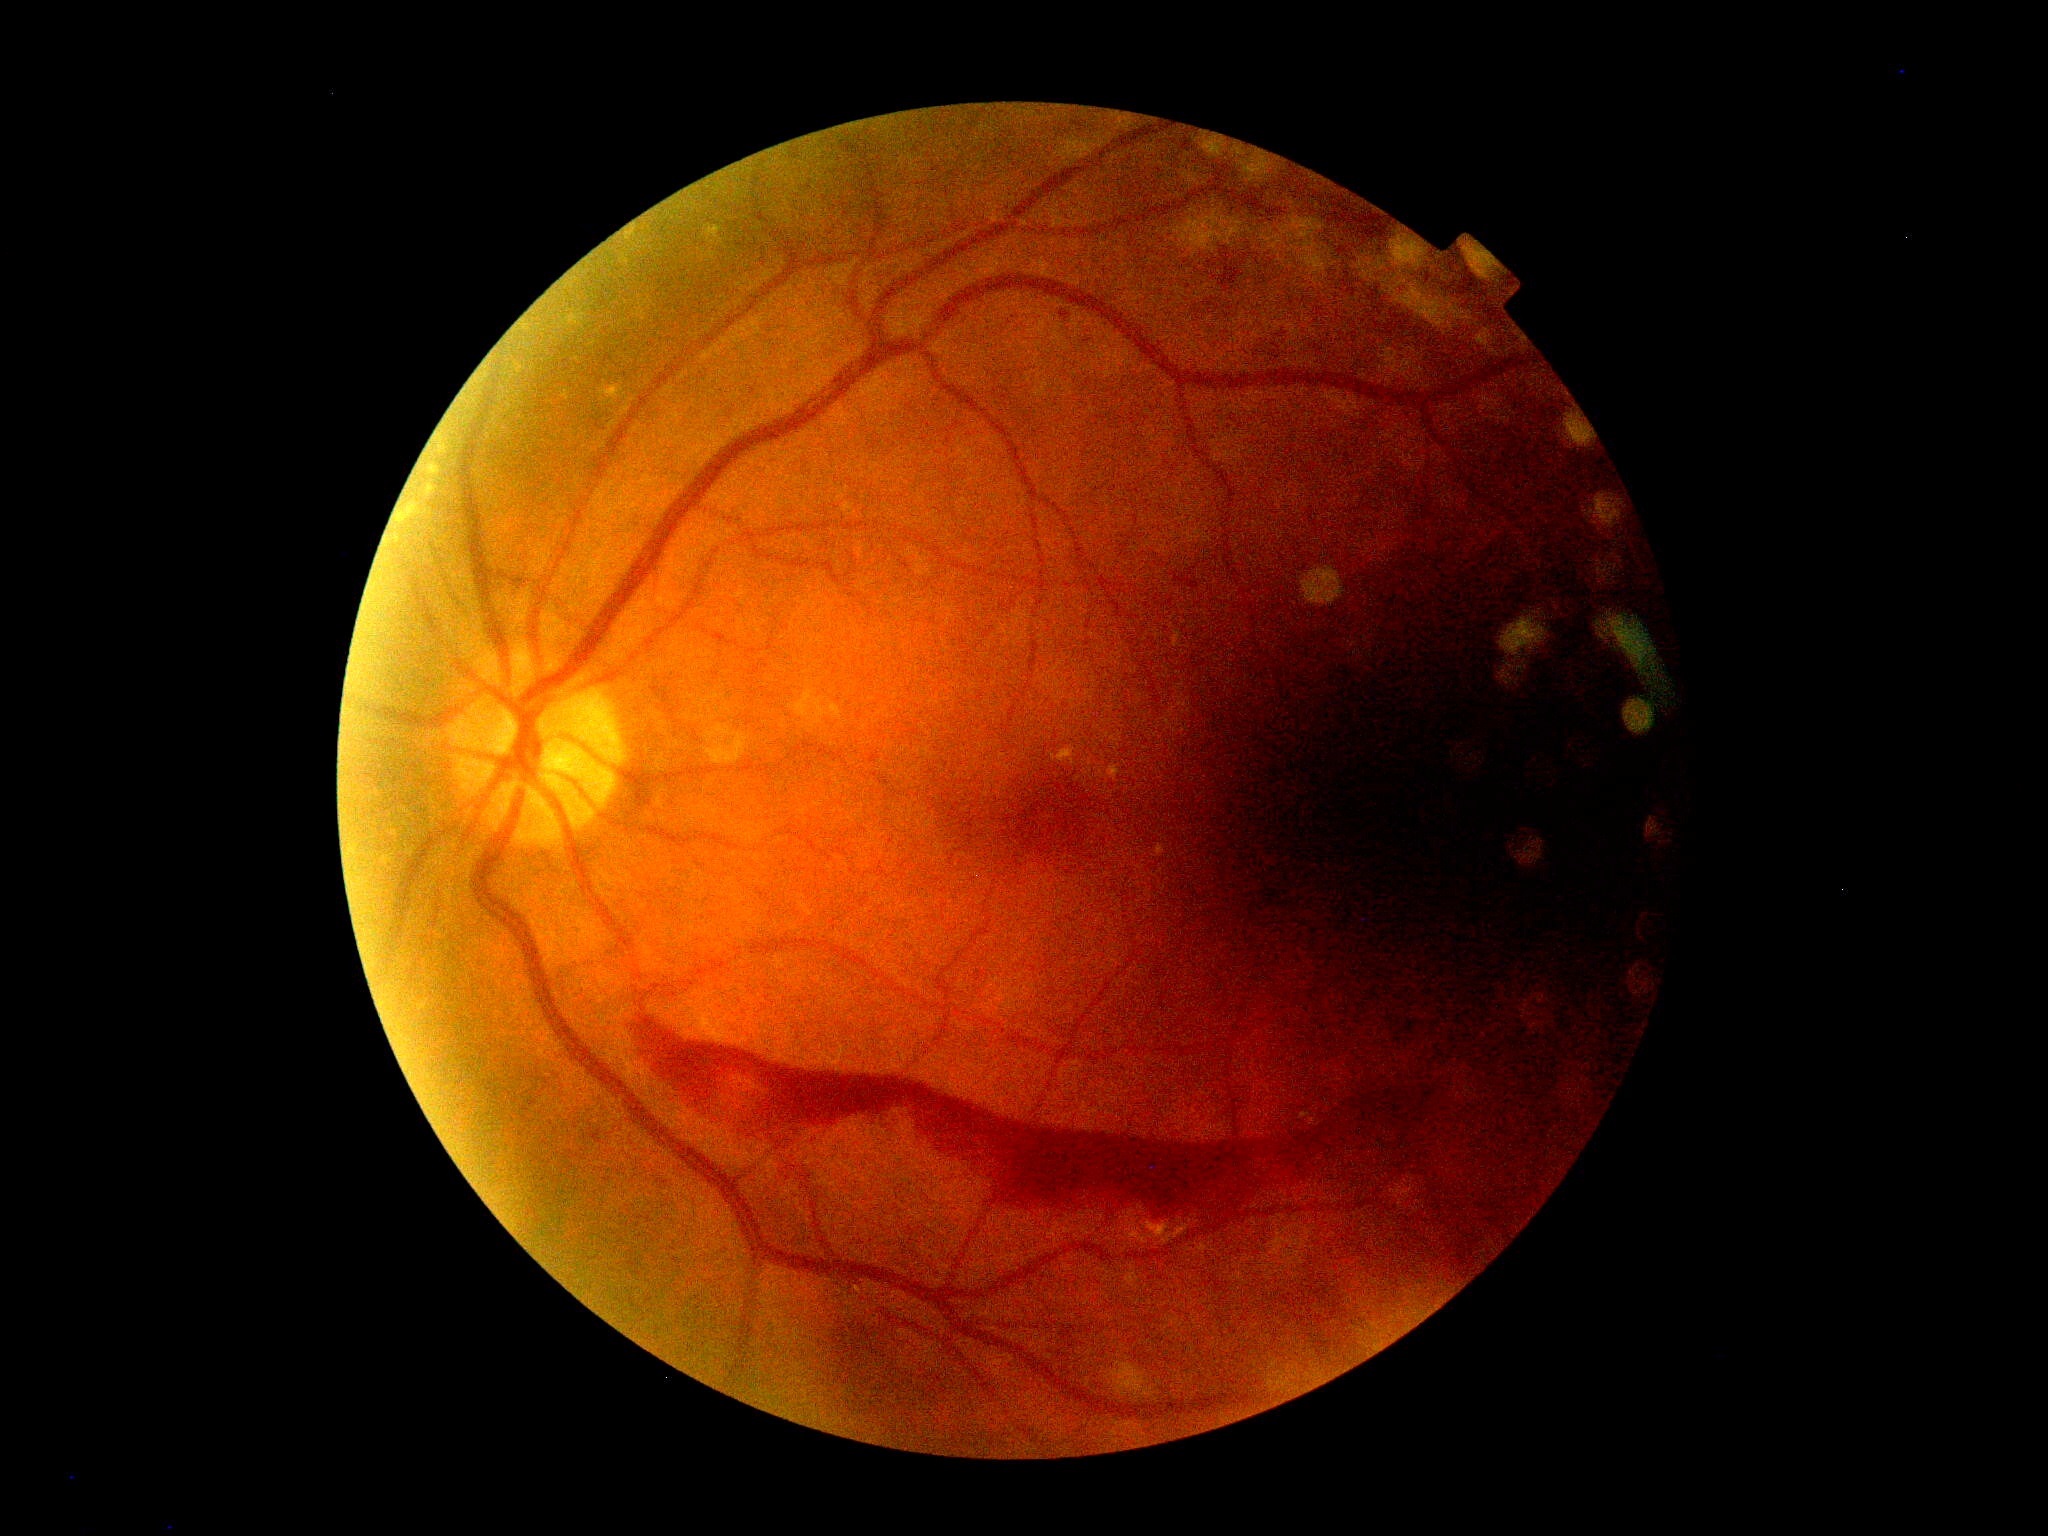

DR stage is 4 — neovascularization and/or vitreous/pre-retinal hemorrhage.